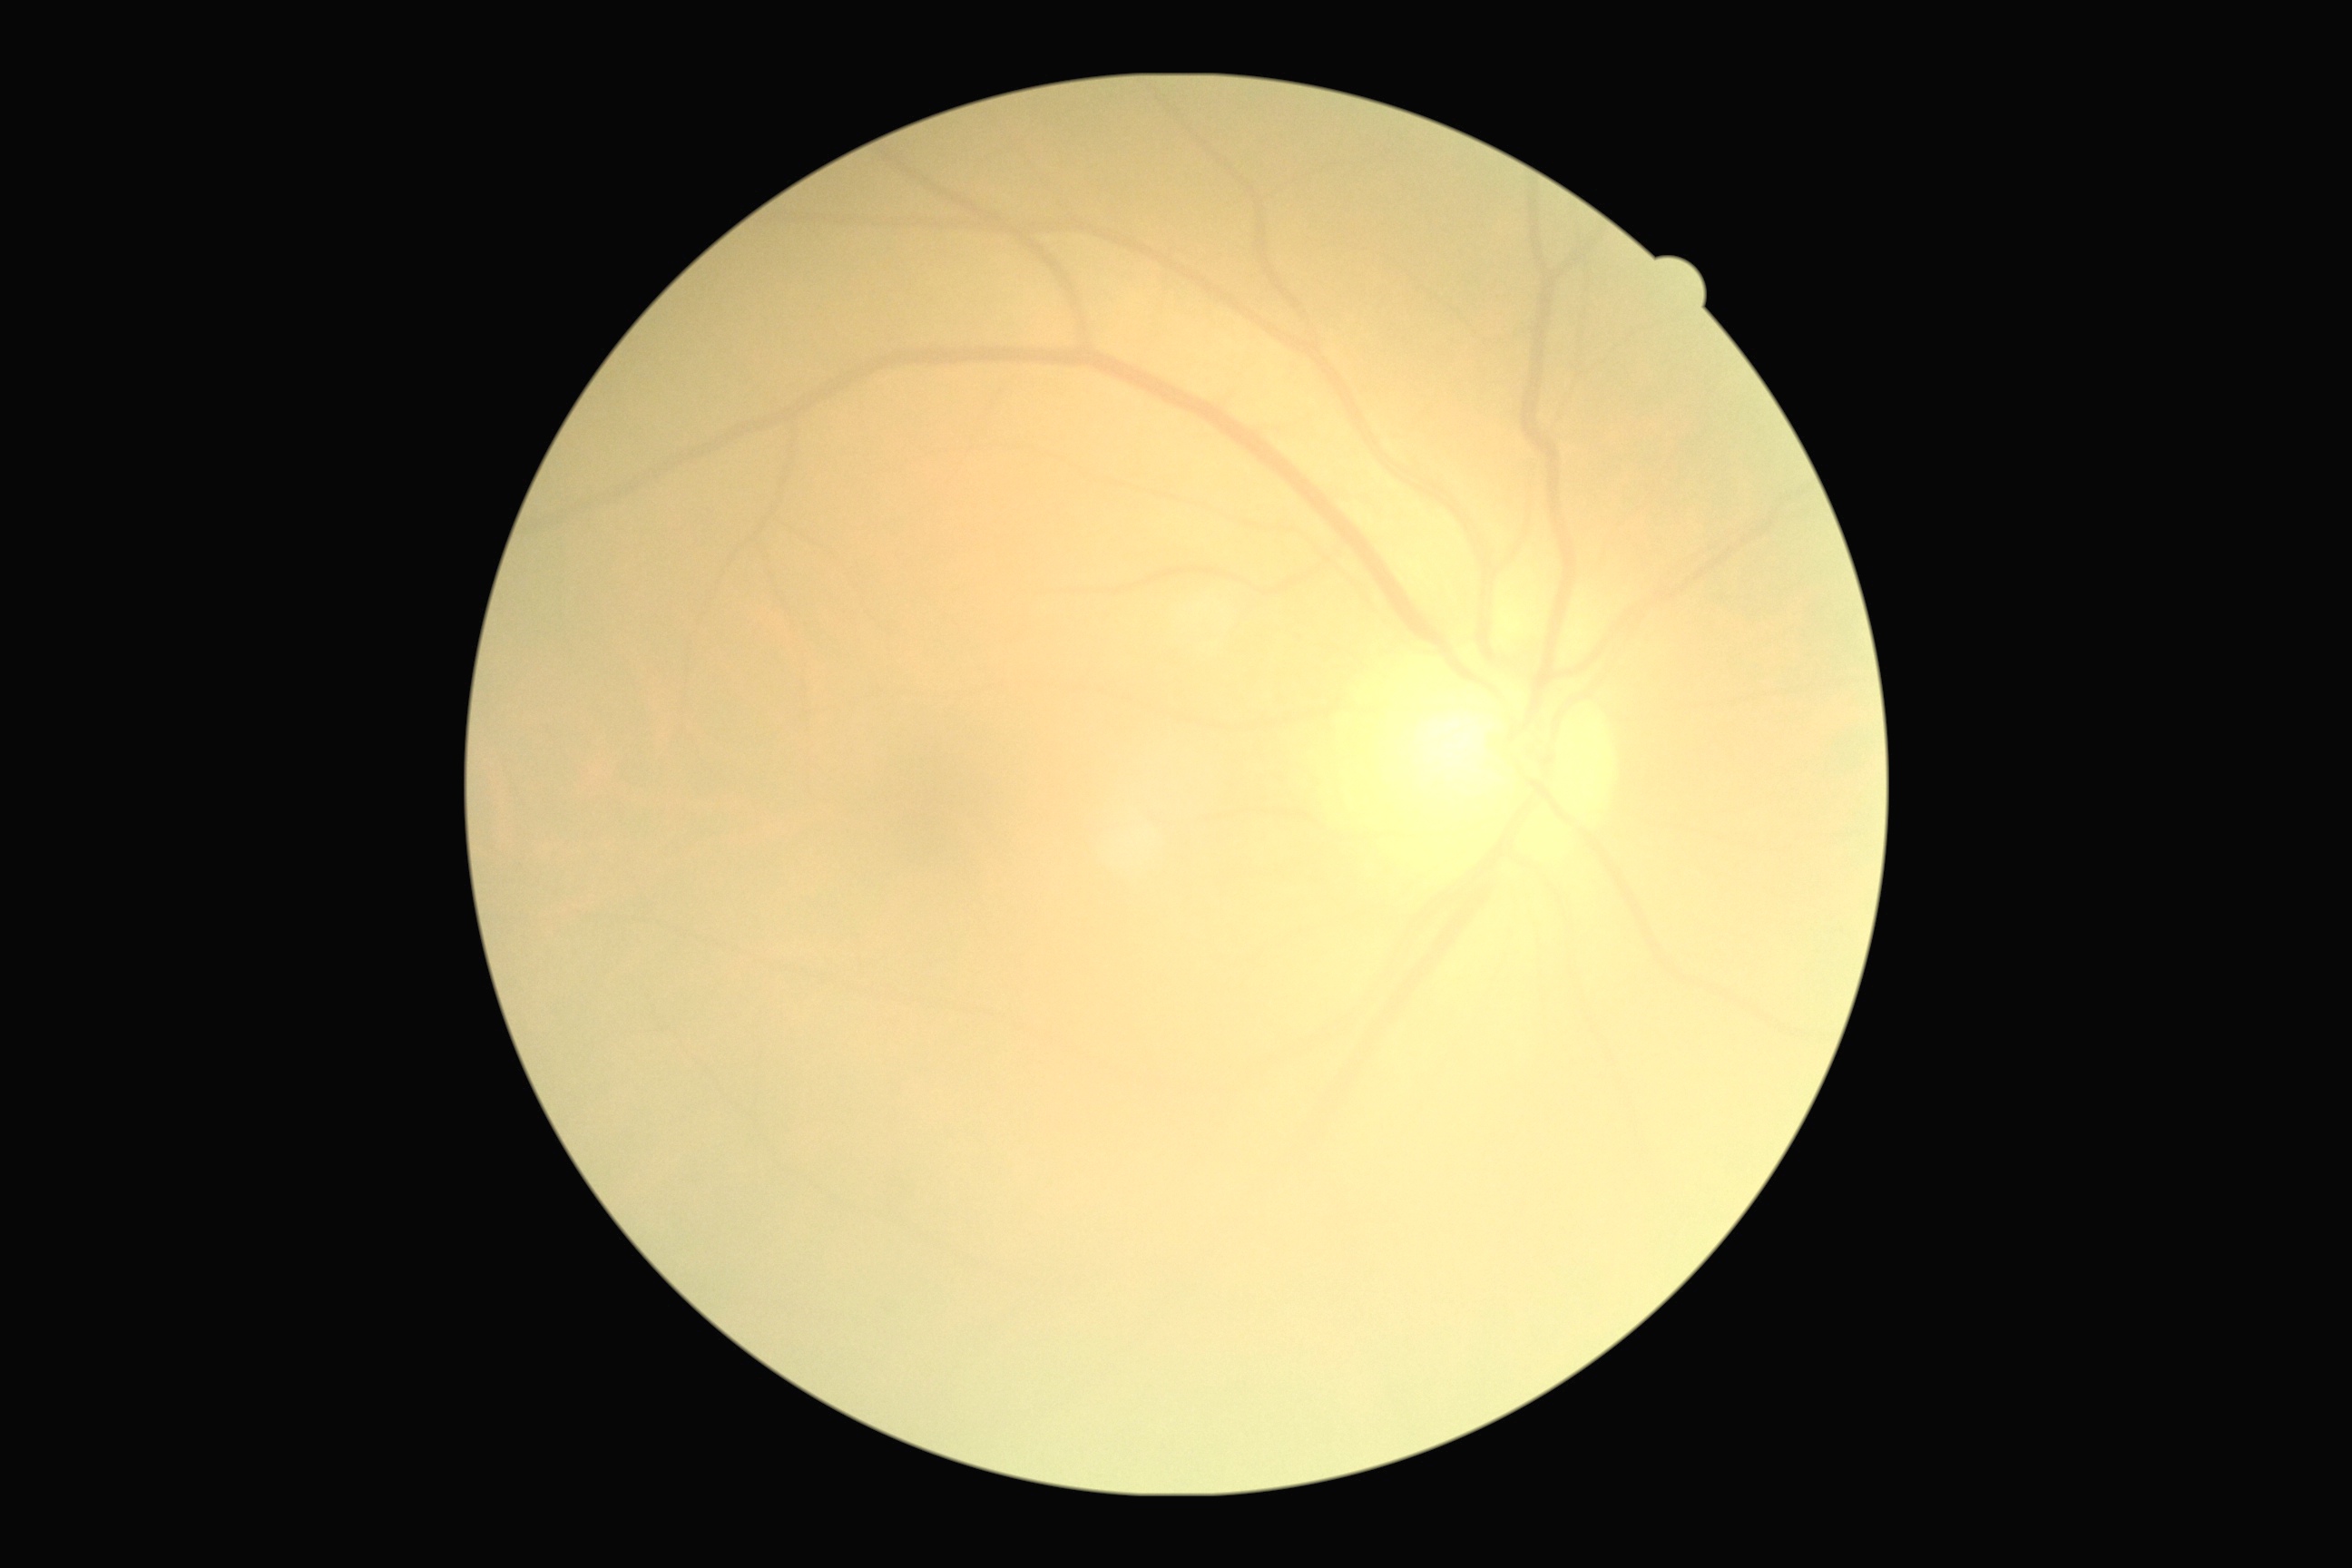 Retinopathy: grade 0 (no apparent retinopathy).
No DR findings.